FOV: 45 degrees: 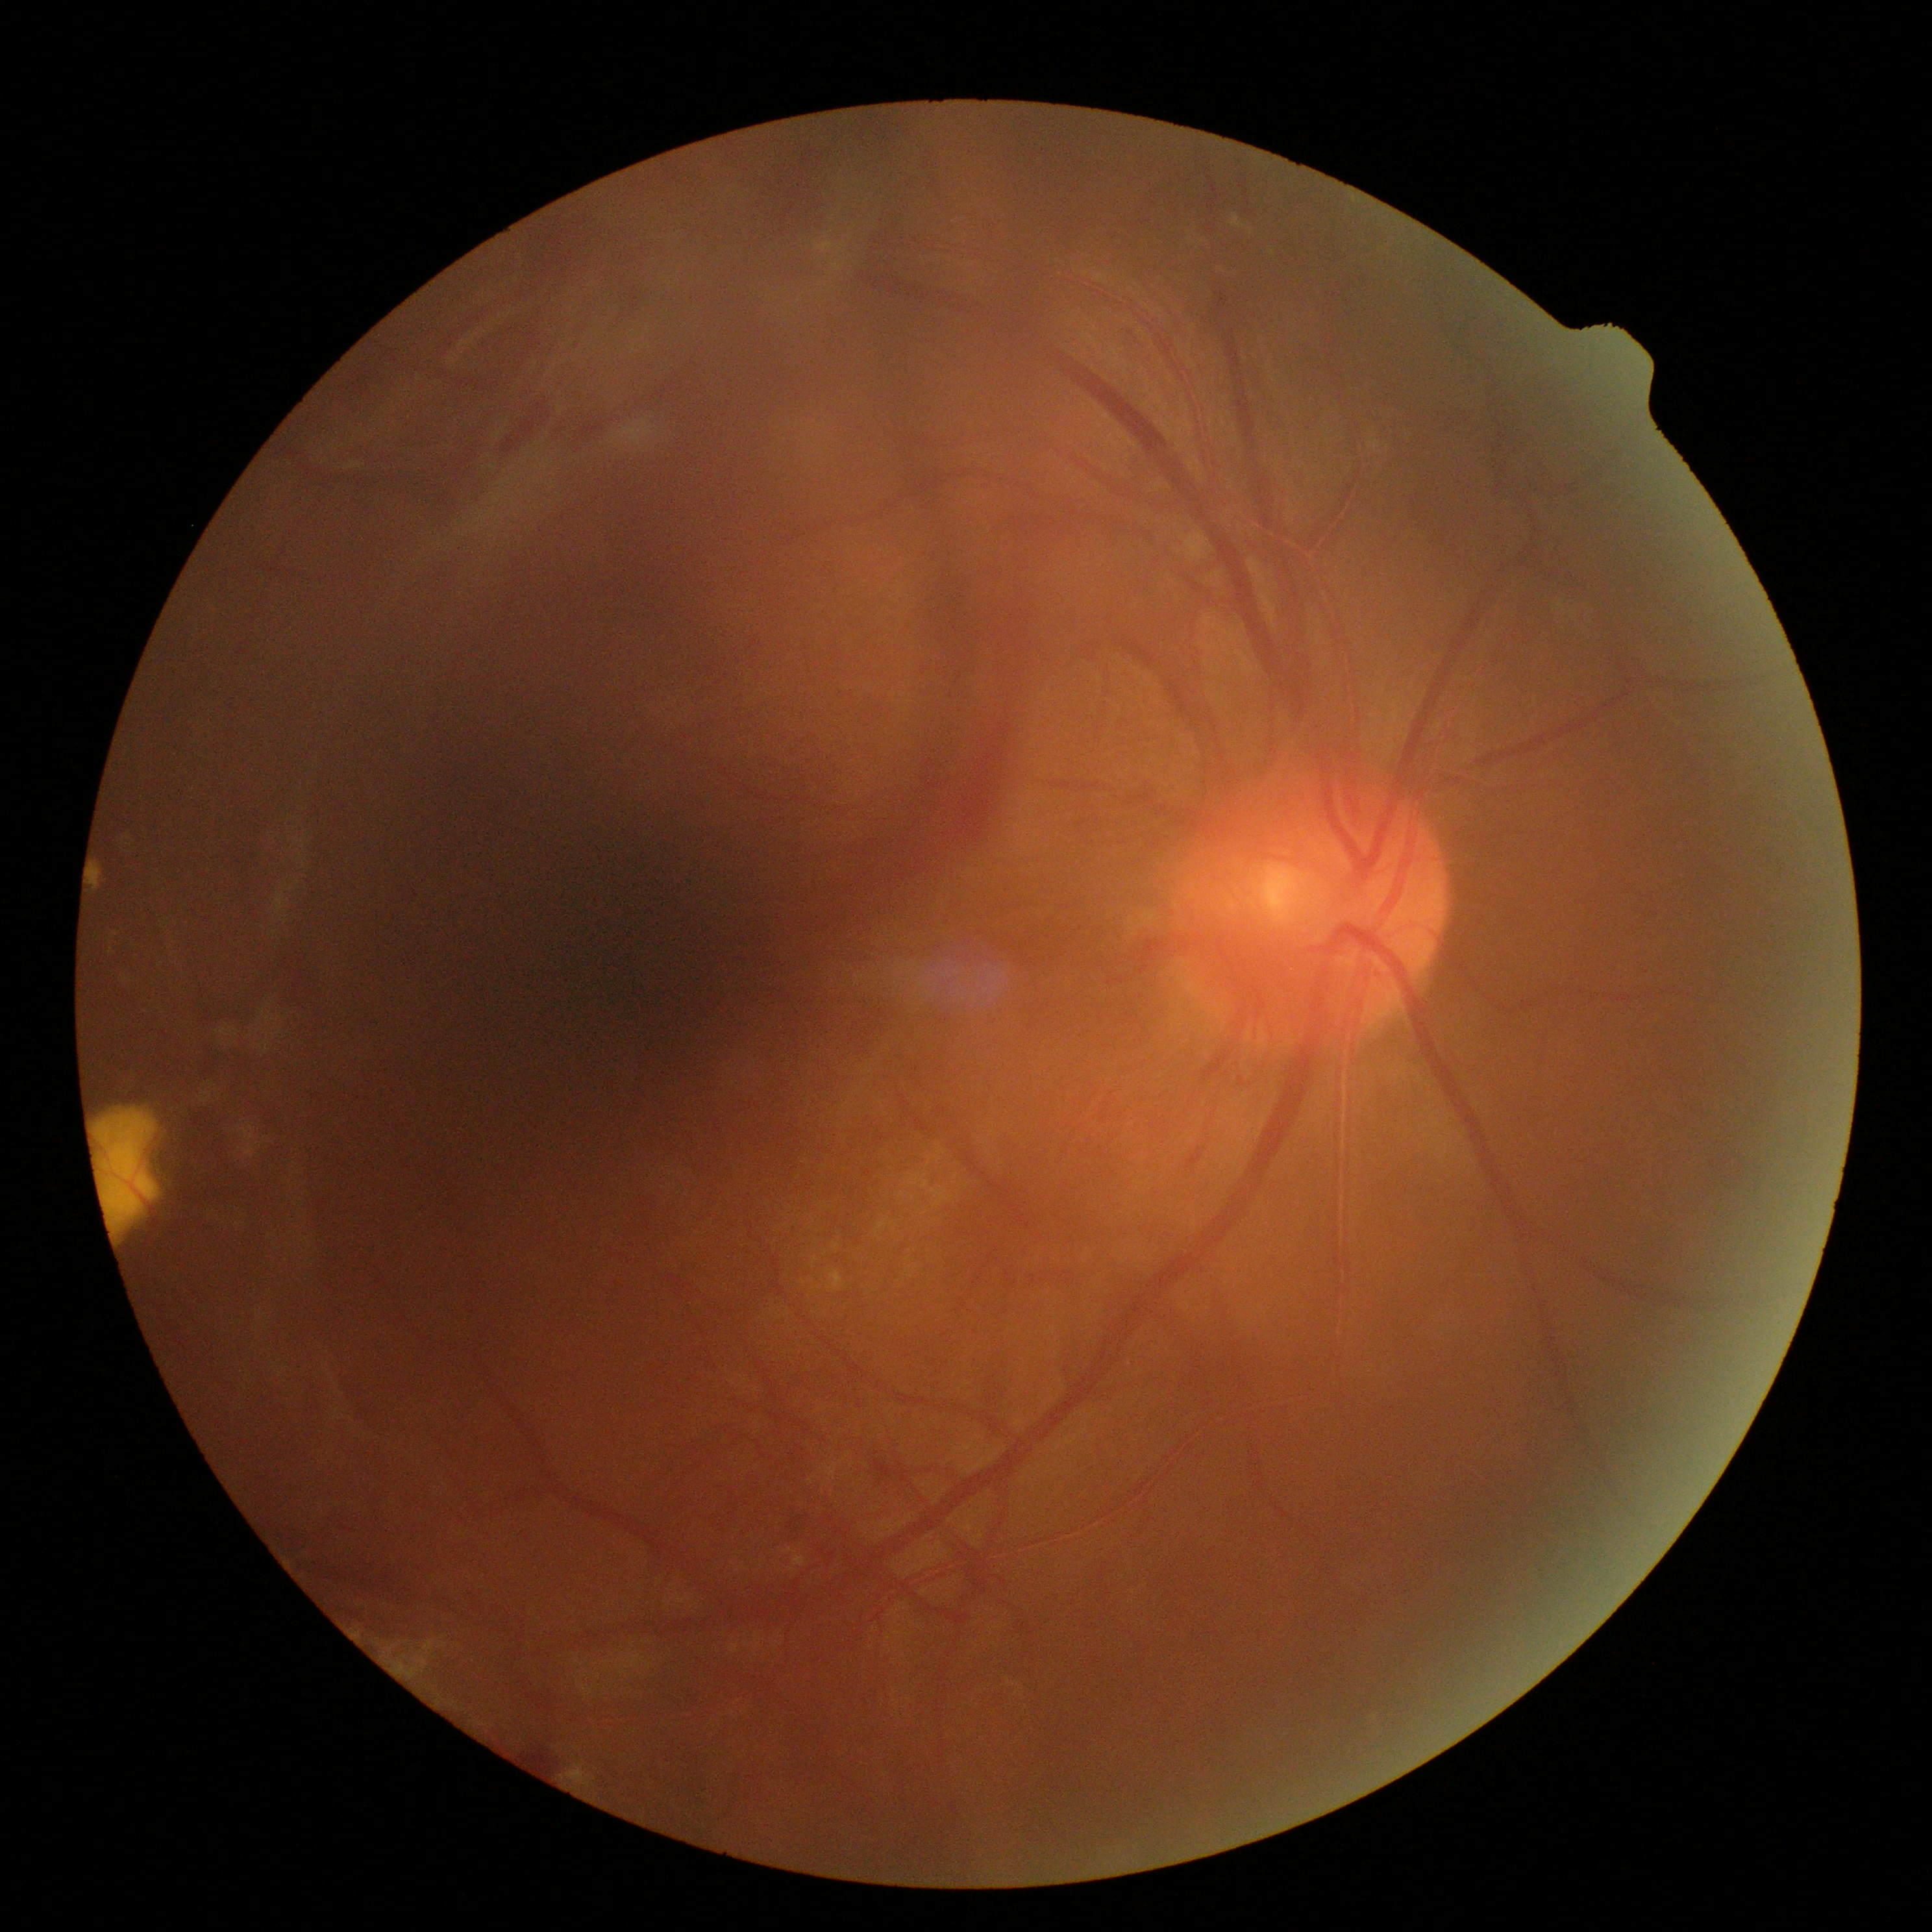
DR grade is 4 (PDR).